50-degree field of view, fundus photo:
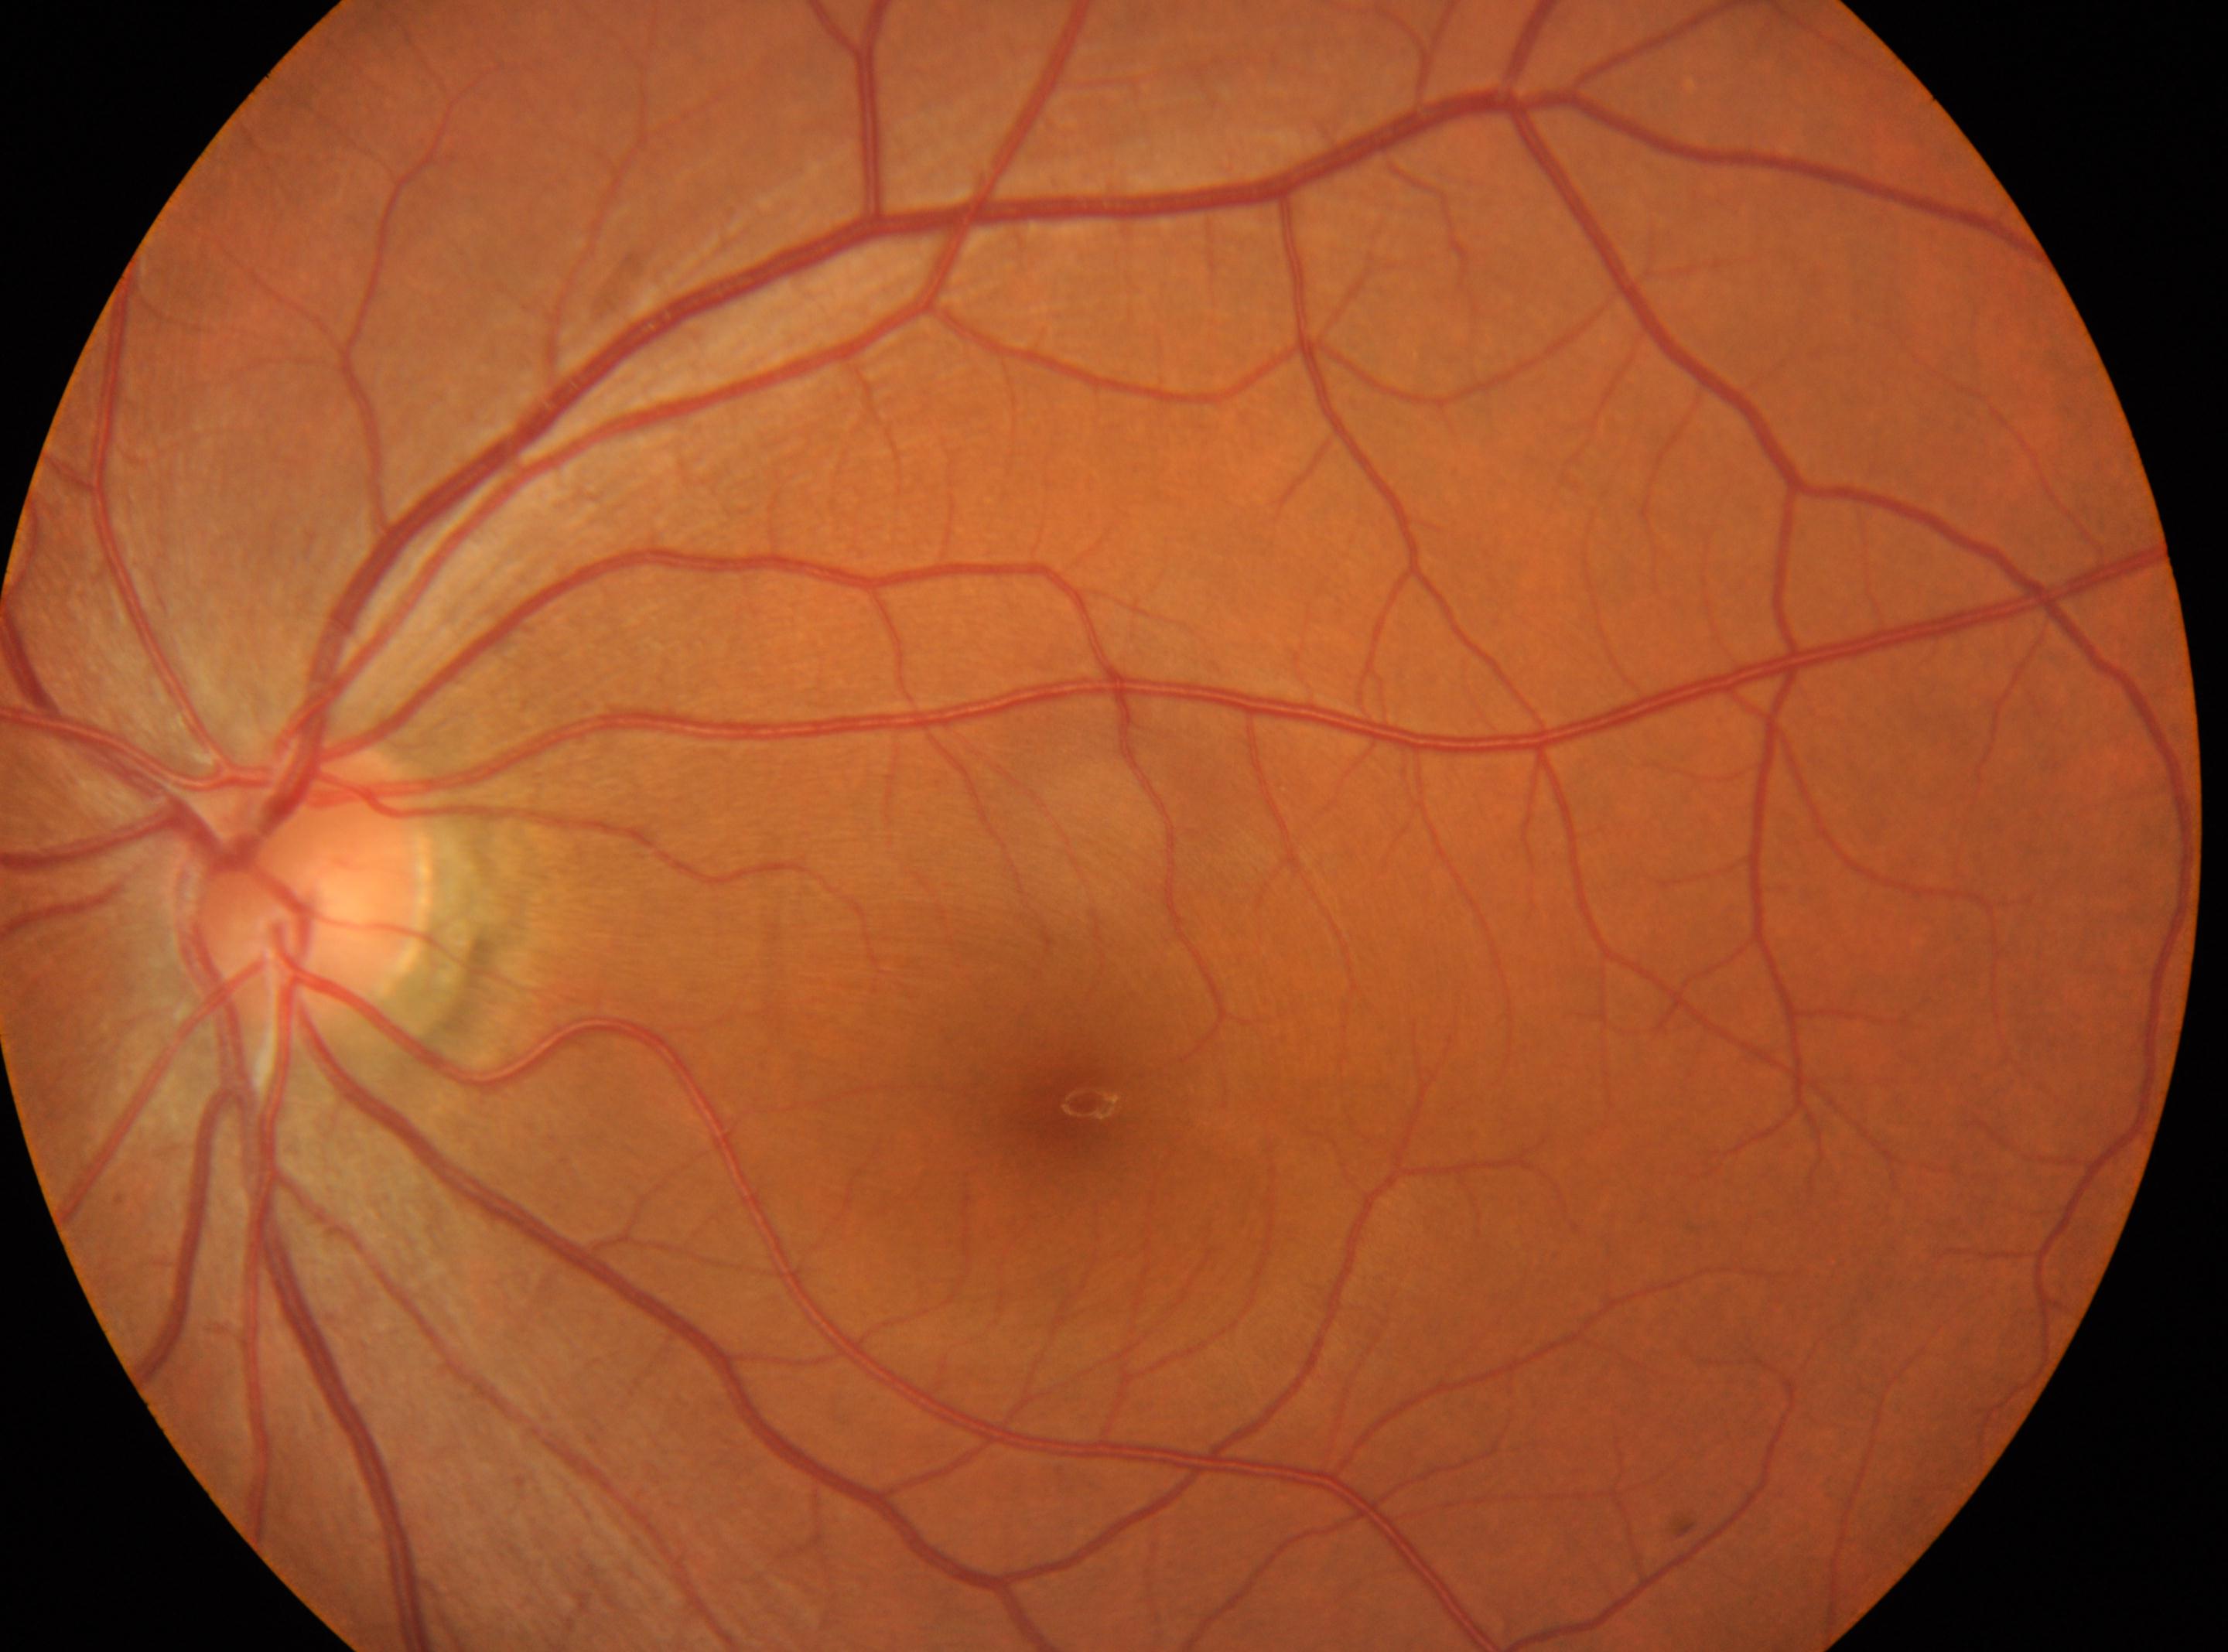 eye = OS; DR stage = 0 — no visible signs of diabetic retinopathy; fovea = (x=1072, y=1104); optic disc = (x=298, y=879).